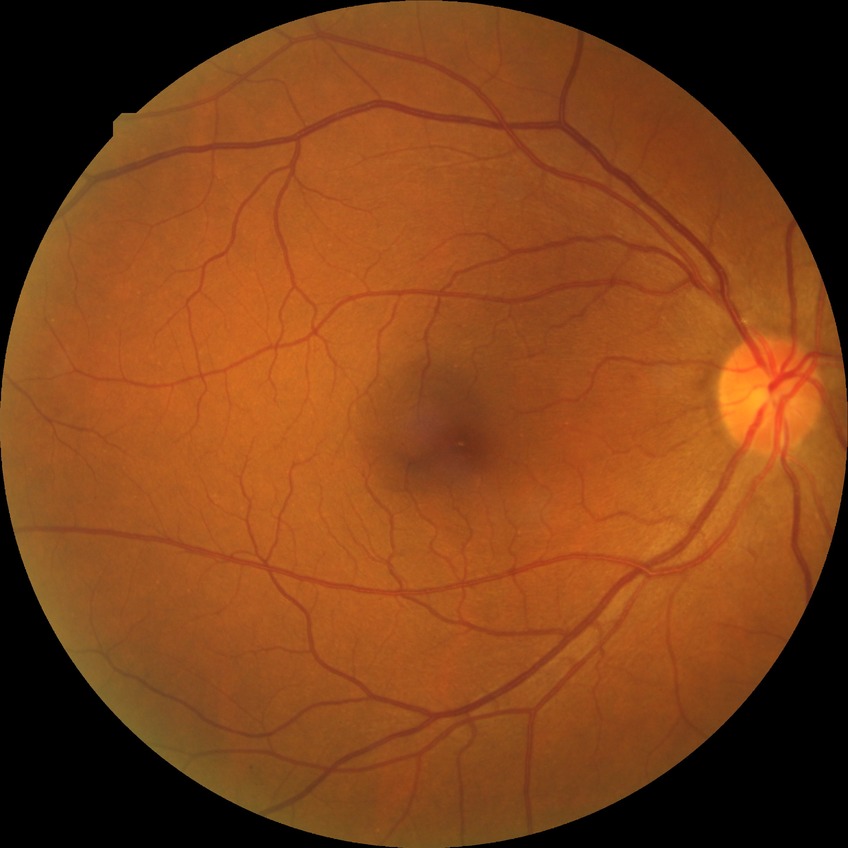

diabetic retinopathy (DR) = no diabetic retinopathy (NDR).